2352 by 1568 pixels. Color fundus photograph. 45-degree field of view — 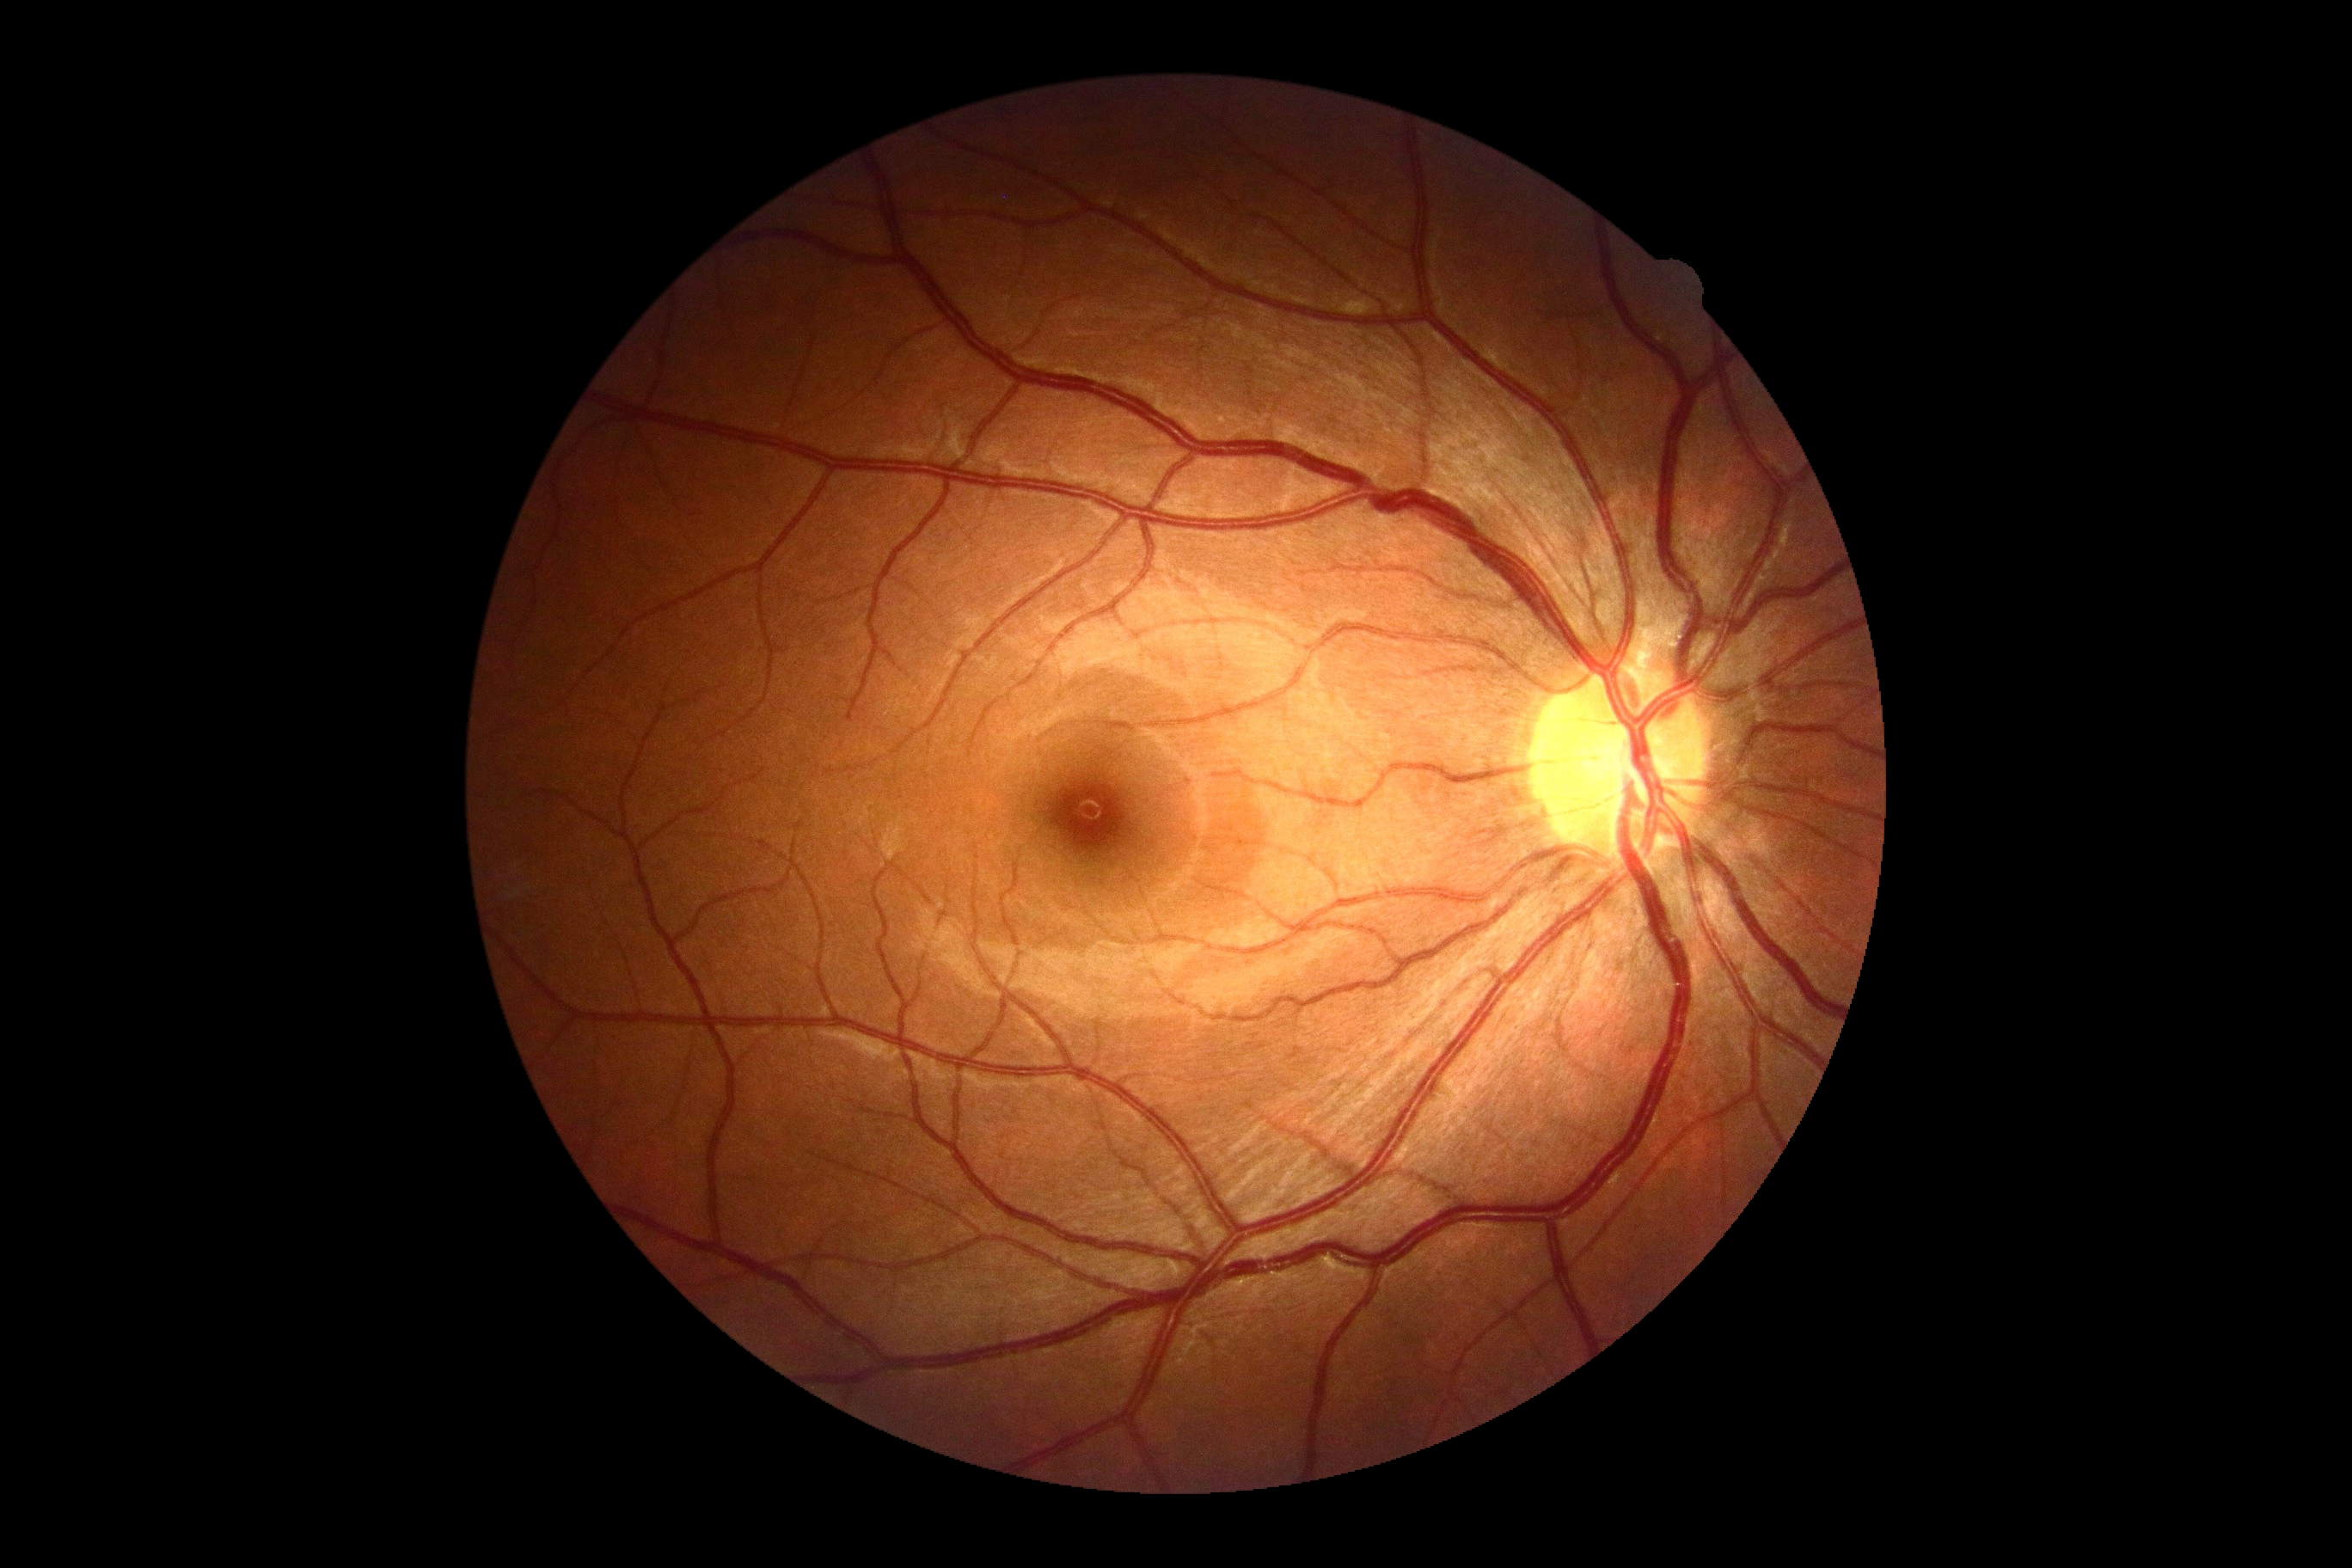
Diabetic retinopathy (DR) is 0/4.